Davis DR grading · 848x848: 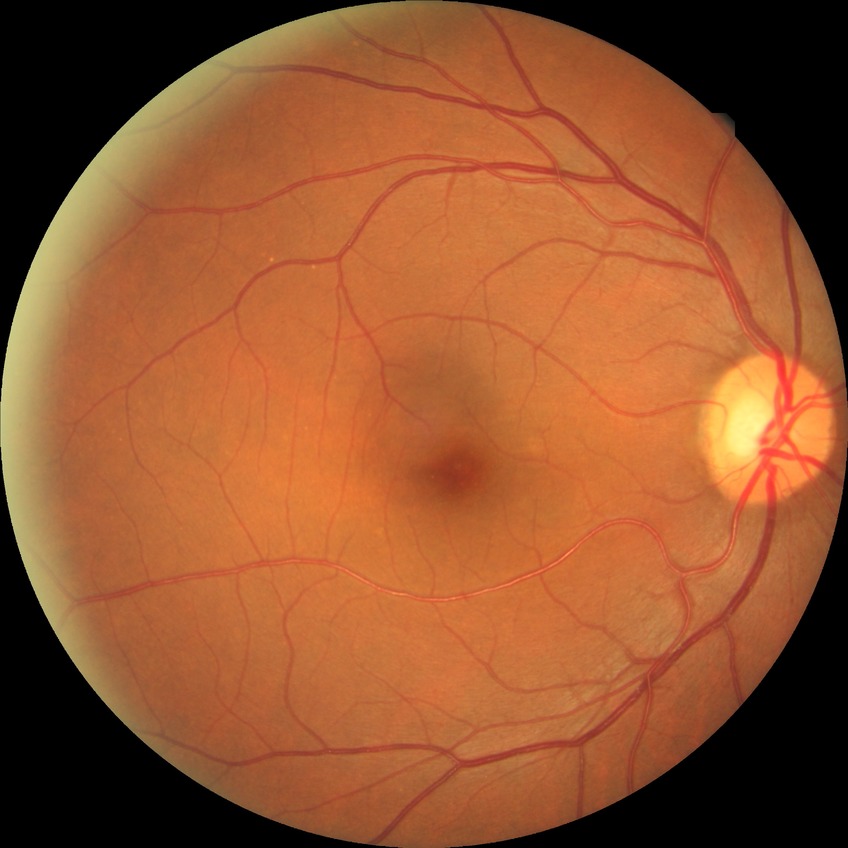
Modified Davis grading is no diabetic retinopathy.